Color fundus image. 2048x1536px — 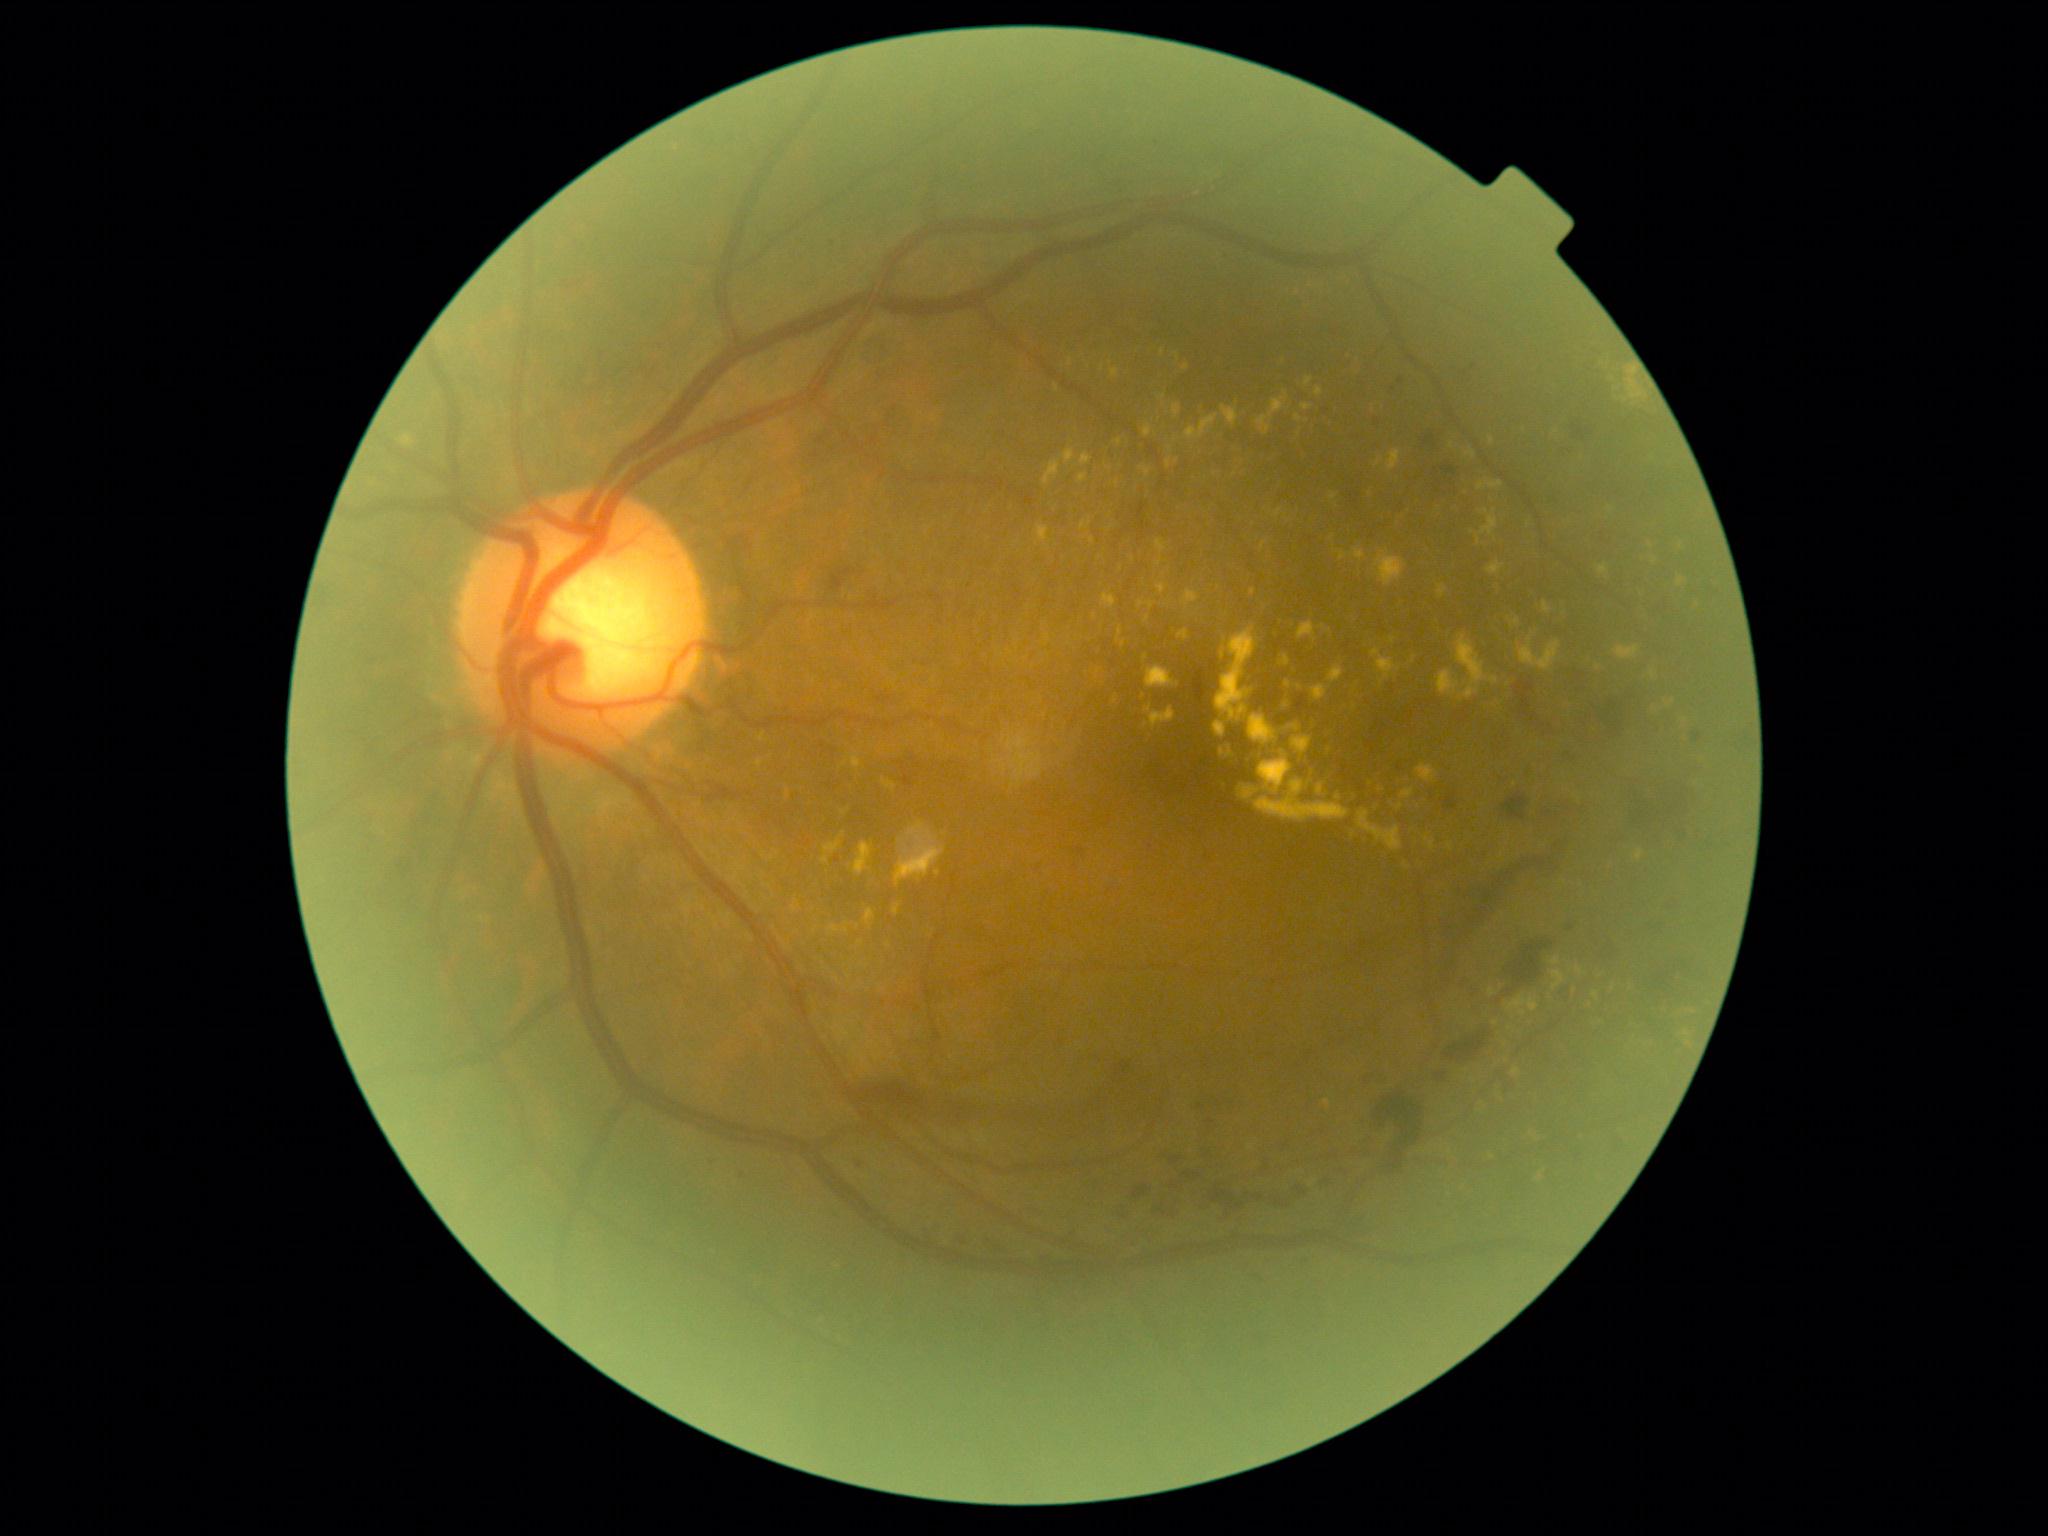

Diabetic retinopathy grade: 2/4.
Hard exudates include {"x1": 1258, "y1": 751, "x2": 1293, "y2": 796}; {"x1": 1576, "y1": 968, "x2": 1585, "y2": 975}; {"x1": 1115, "y1": 439, "x2": 1123, "y2": 445}; {"x1": 841, "y1": 809, "x2": 851, "y2": 816}; {"x1": 1222, "y1": 406, "x2": 1238, "y2": 426}; {"x1": 1637, "y1": 849, "x2": 1644, "y2": 861}; {"x1": 1487, "y1": 561, "x2": 1504, "y2": 575}; {"x1": 1173, "y1": 405, "x2": 1182, "y2": 418}; {"x1": 1111, "y1": 369, "x2": 1120, "y2": 379}; {"x1": 821, "y1": 834, "x2": 845, "y2": 864}; {"x1": 1139, "y1": 601, "x2": 1156, "y2": 610}.
Small hard exudates approximately at point(1492, 1157); point(1686, 1046); point(1057, 389); point(764, 856); point(1393, 641); point(1381, 790); point(1144, 697); point(847, 930).